Optic disc photograph:
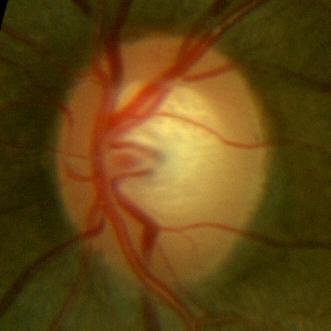
No glaucomatous changes.